45 degree fundus photograph; diabetic retinopathy graded by the modified Davis classification:
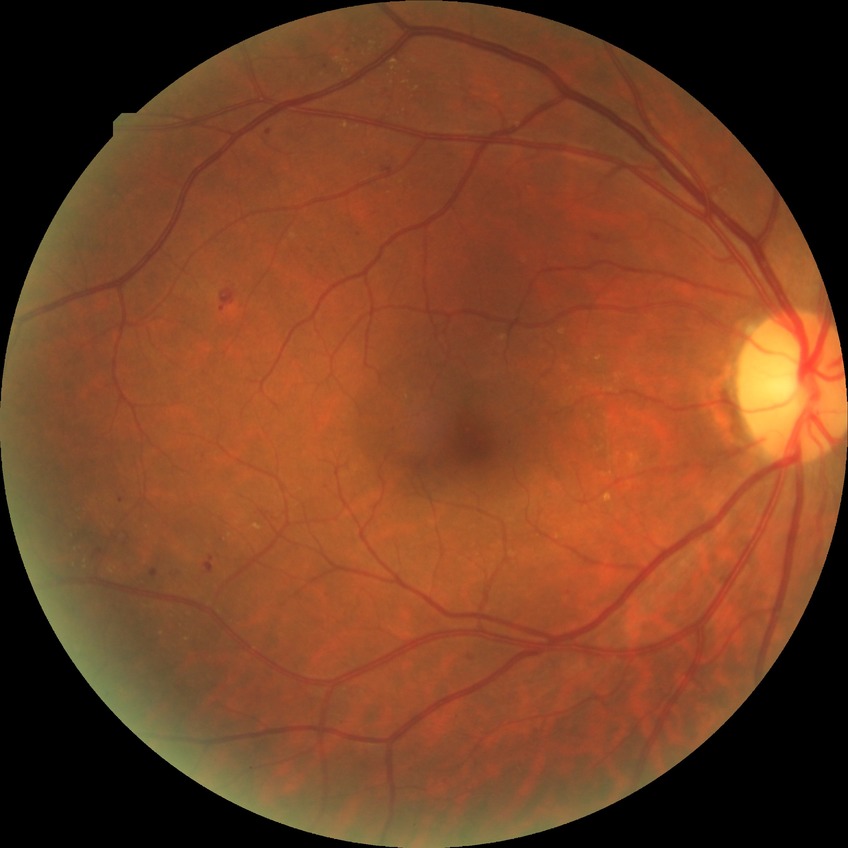 Diabetic retinopathy (DR) is SDR (simple diabetic retinopathy).